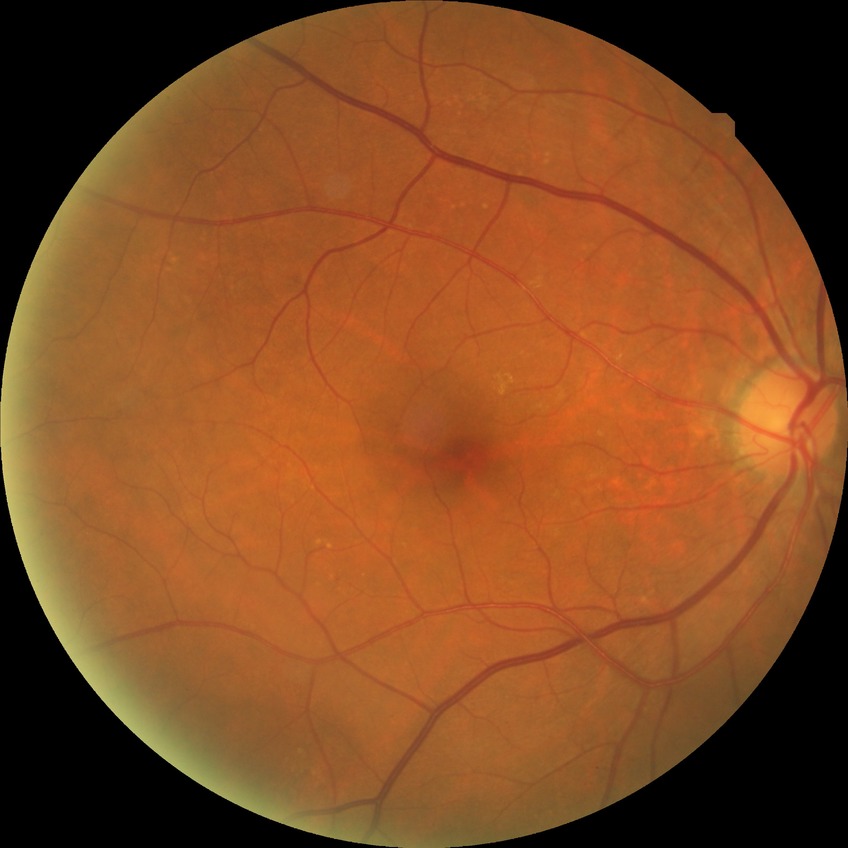
retinopathy stage = no diabetic retinopathy.